45° FOV: 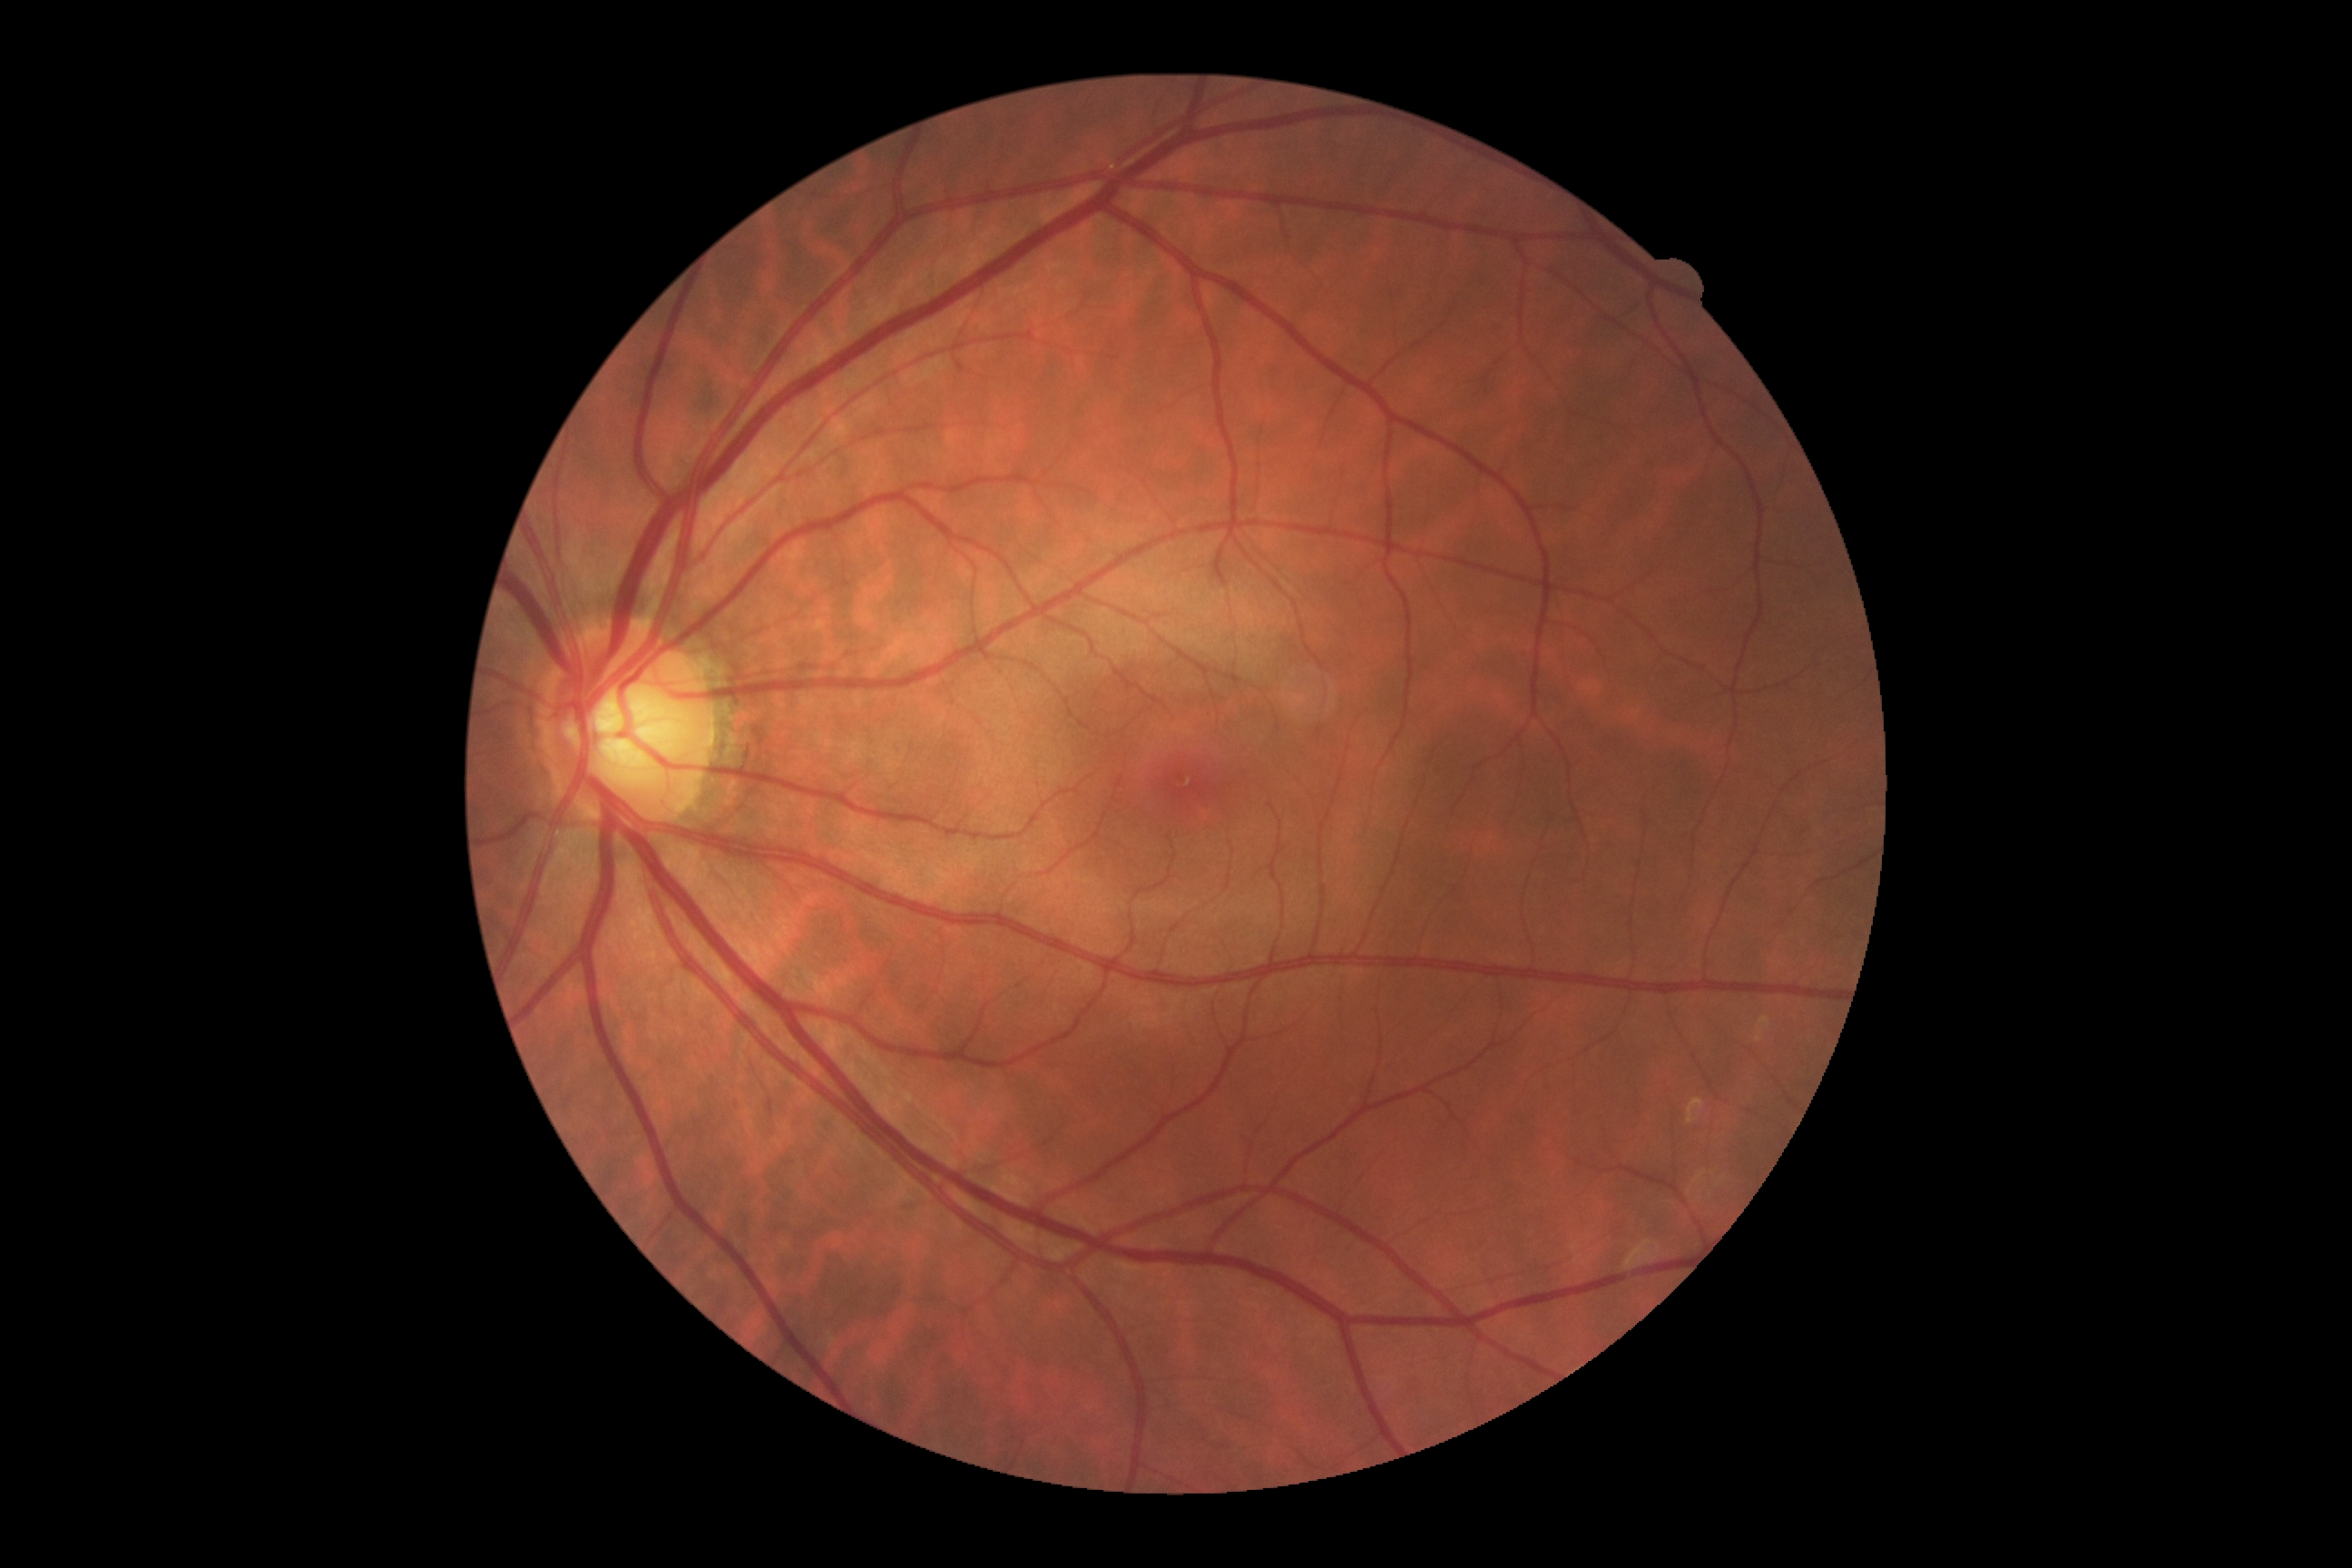
DR: 0/4.